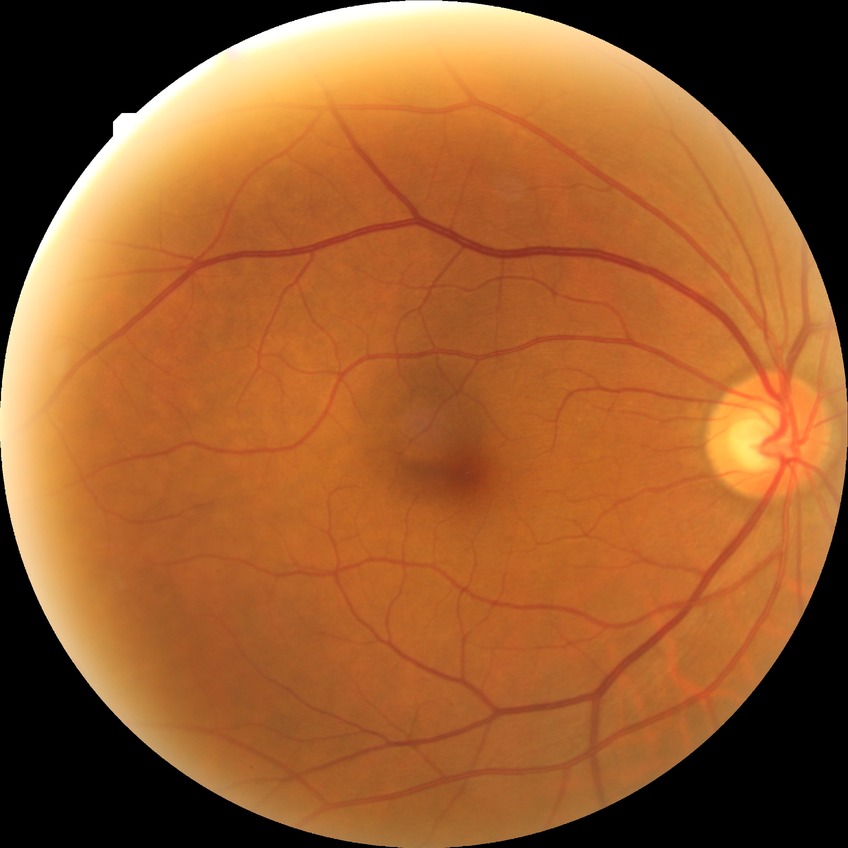 Diabetic retinopathy (DR) is no diabetic retinopathy (NDR).